Wide-field fundus image from infant ROP screening: 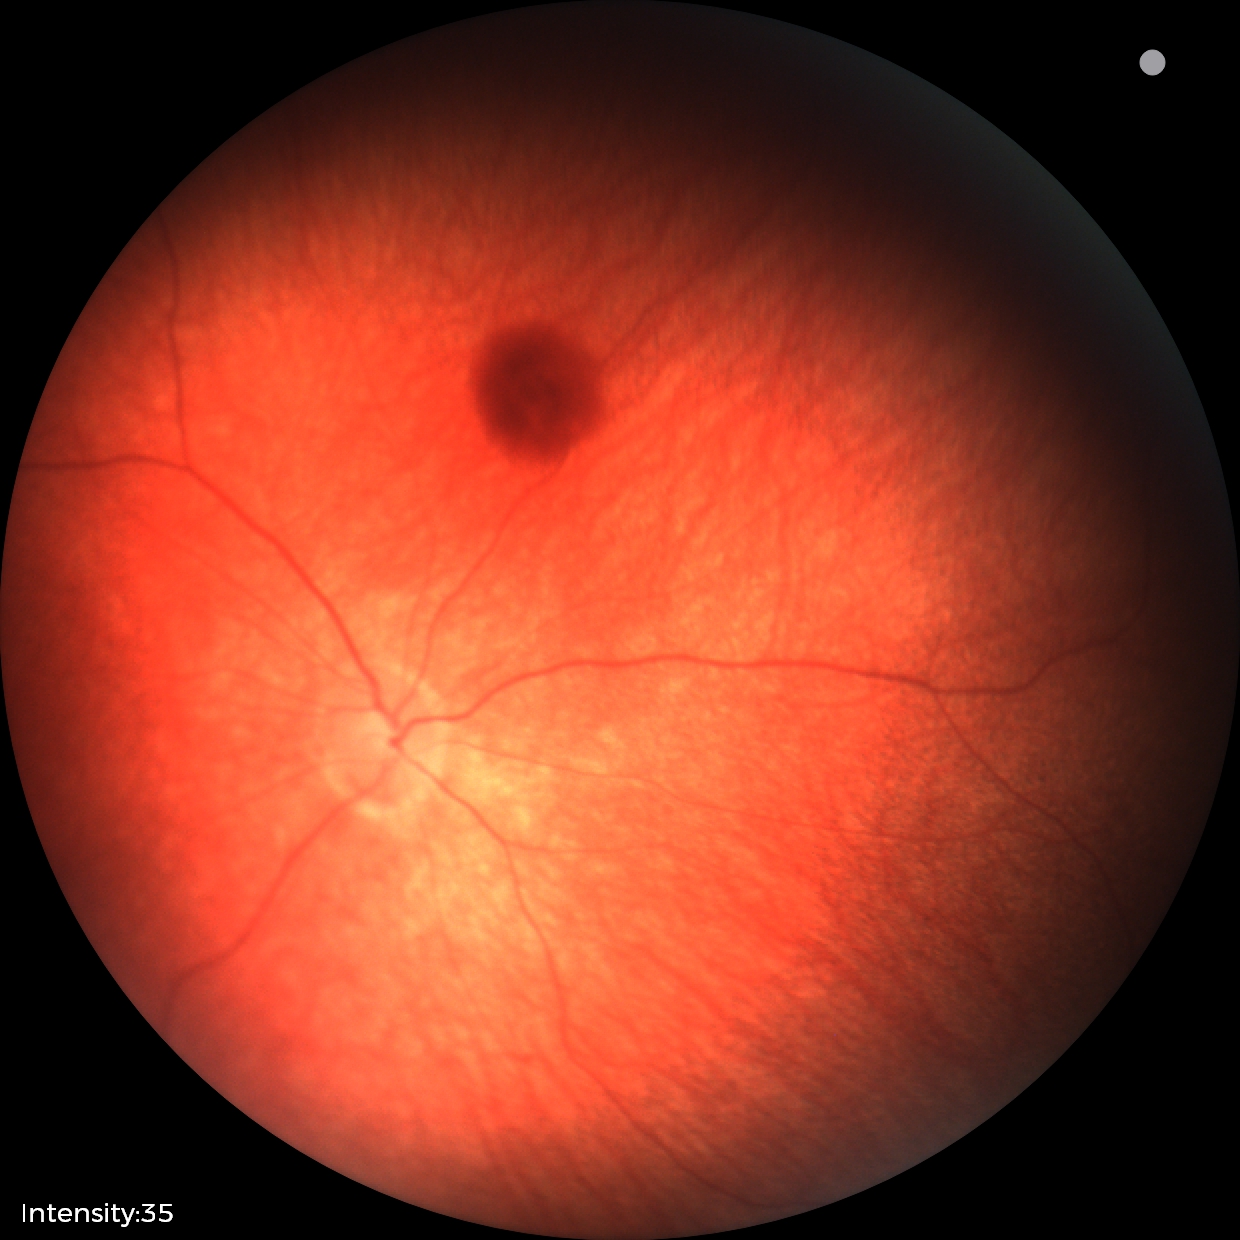

Impression: retinal hemorrhages